848x848, DR severity per modified Davis staging.
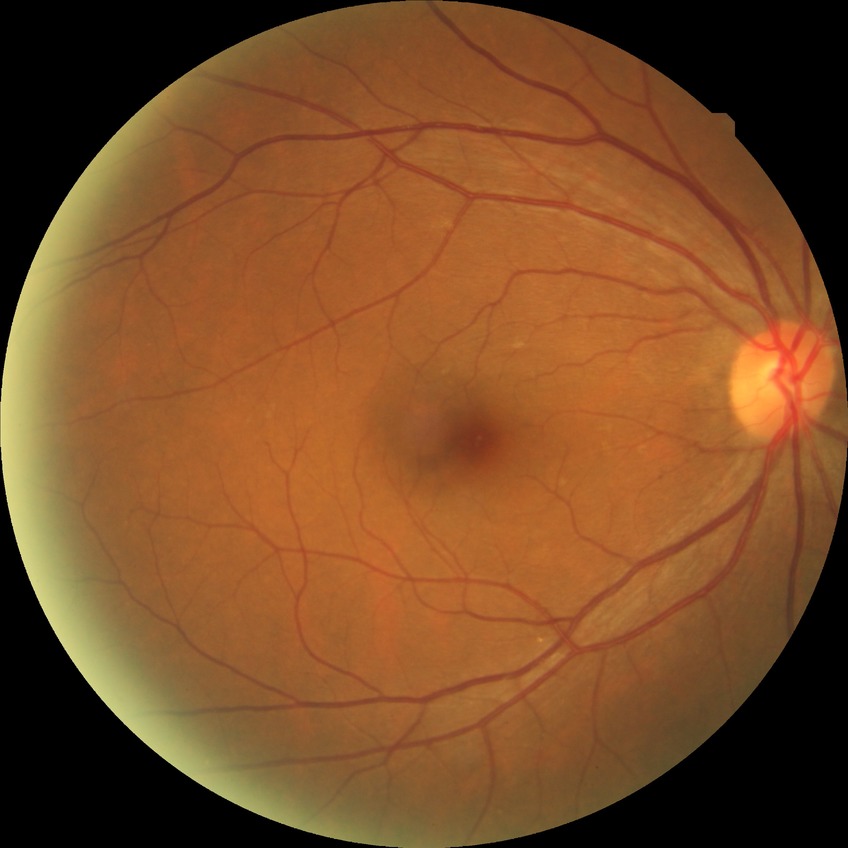 Diabetic retinopathy (DR): no diabetic retinopathy (NDR).